45° FOV. 1920 by 1088 pixels. Color fundus image — 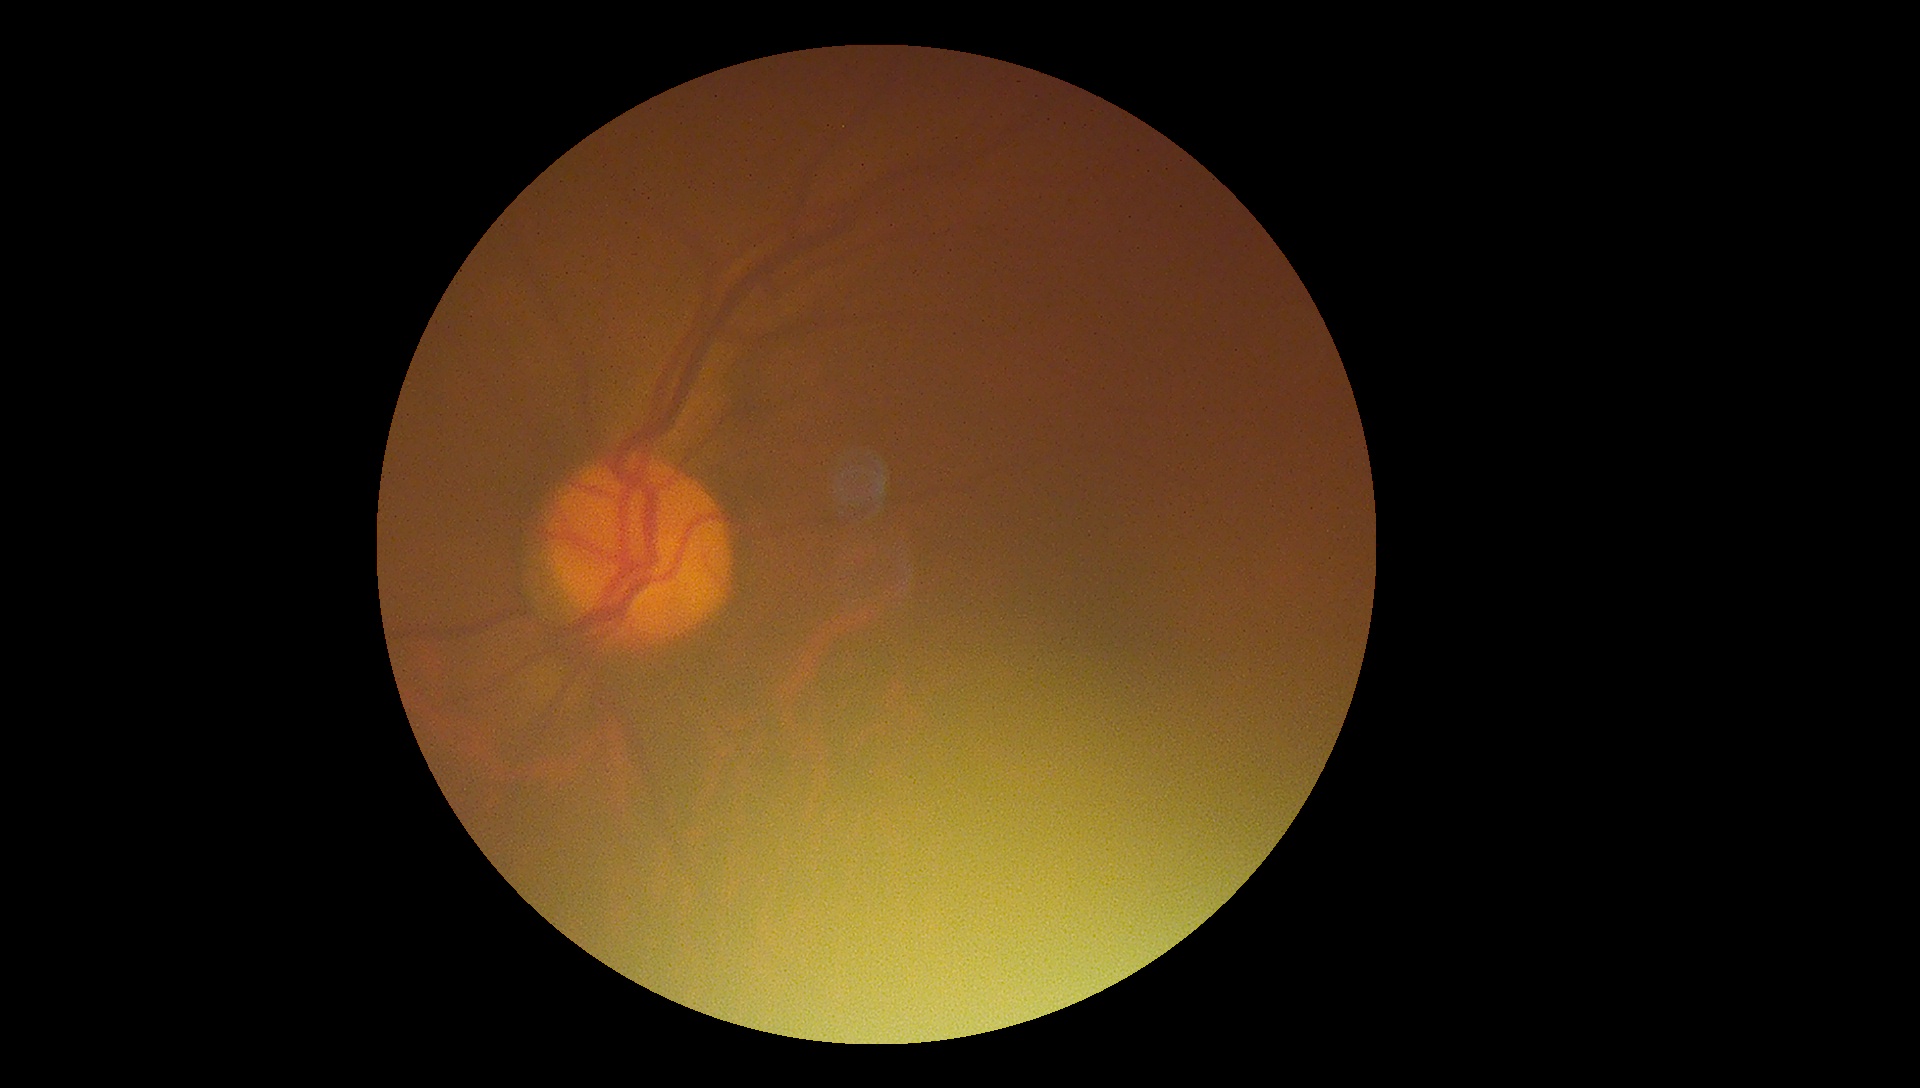
Ungradable image — DR severity cannot be determined. Diabetic retinopathy severity is ungradable due to poor image quality.